NIDEK AFC-230, no pharmacologic dilation, color fundus photograph, modified Davis classification
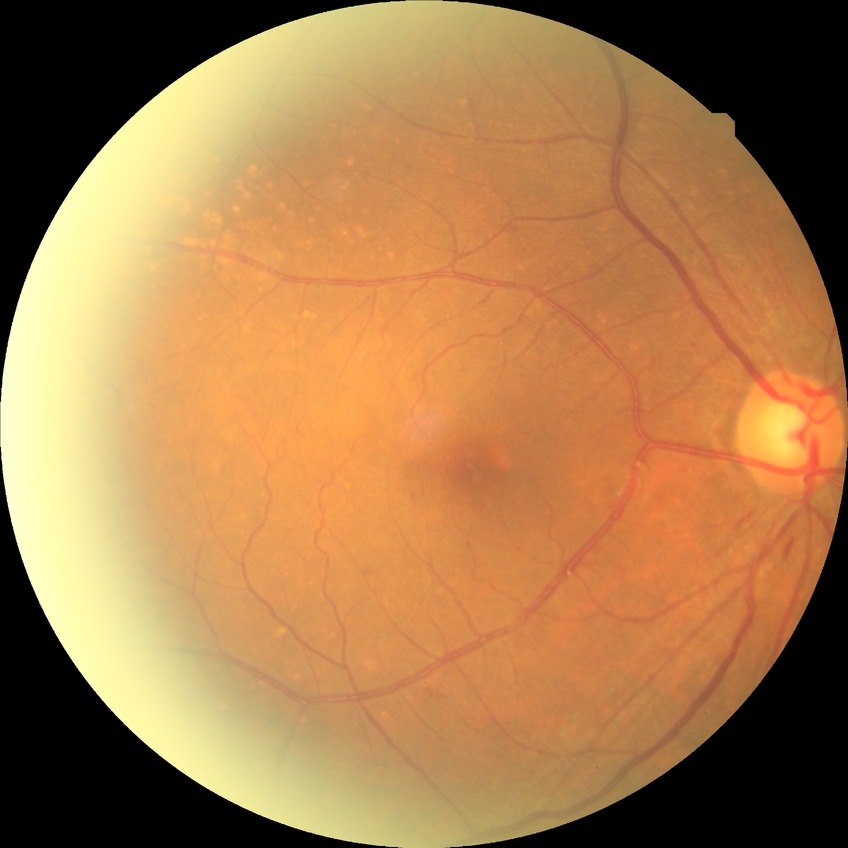 davis_grade: simple diabetic retinopathy
proliferative_class: non-proliferative diabetic retinopathy